2048x1536px
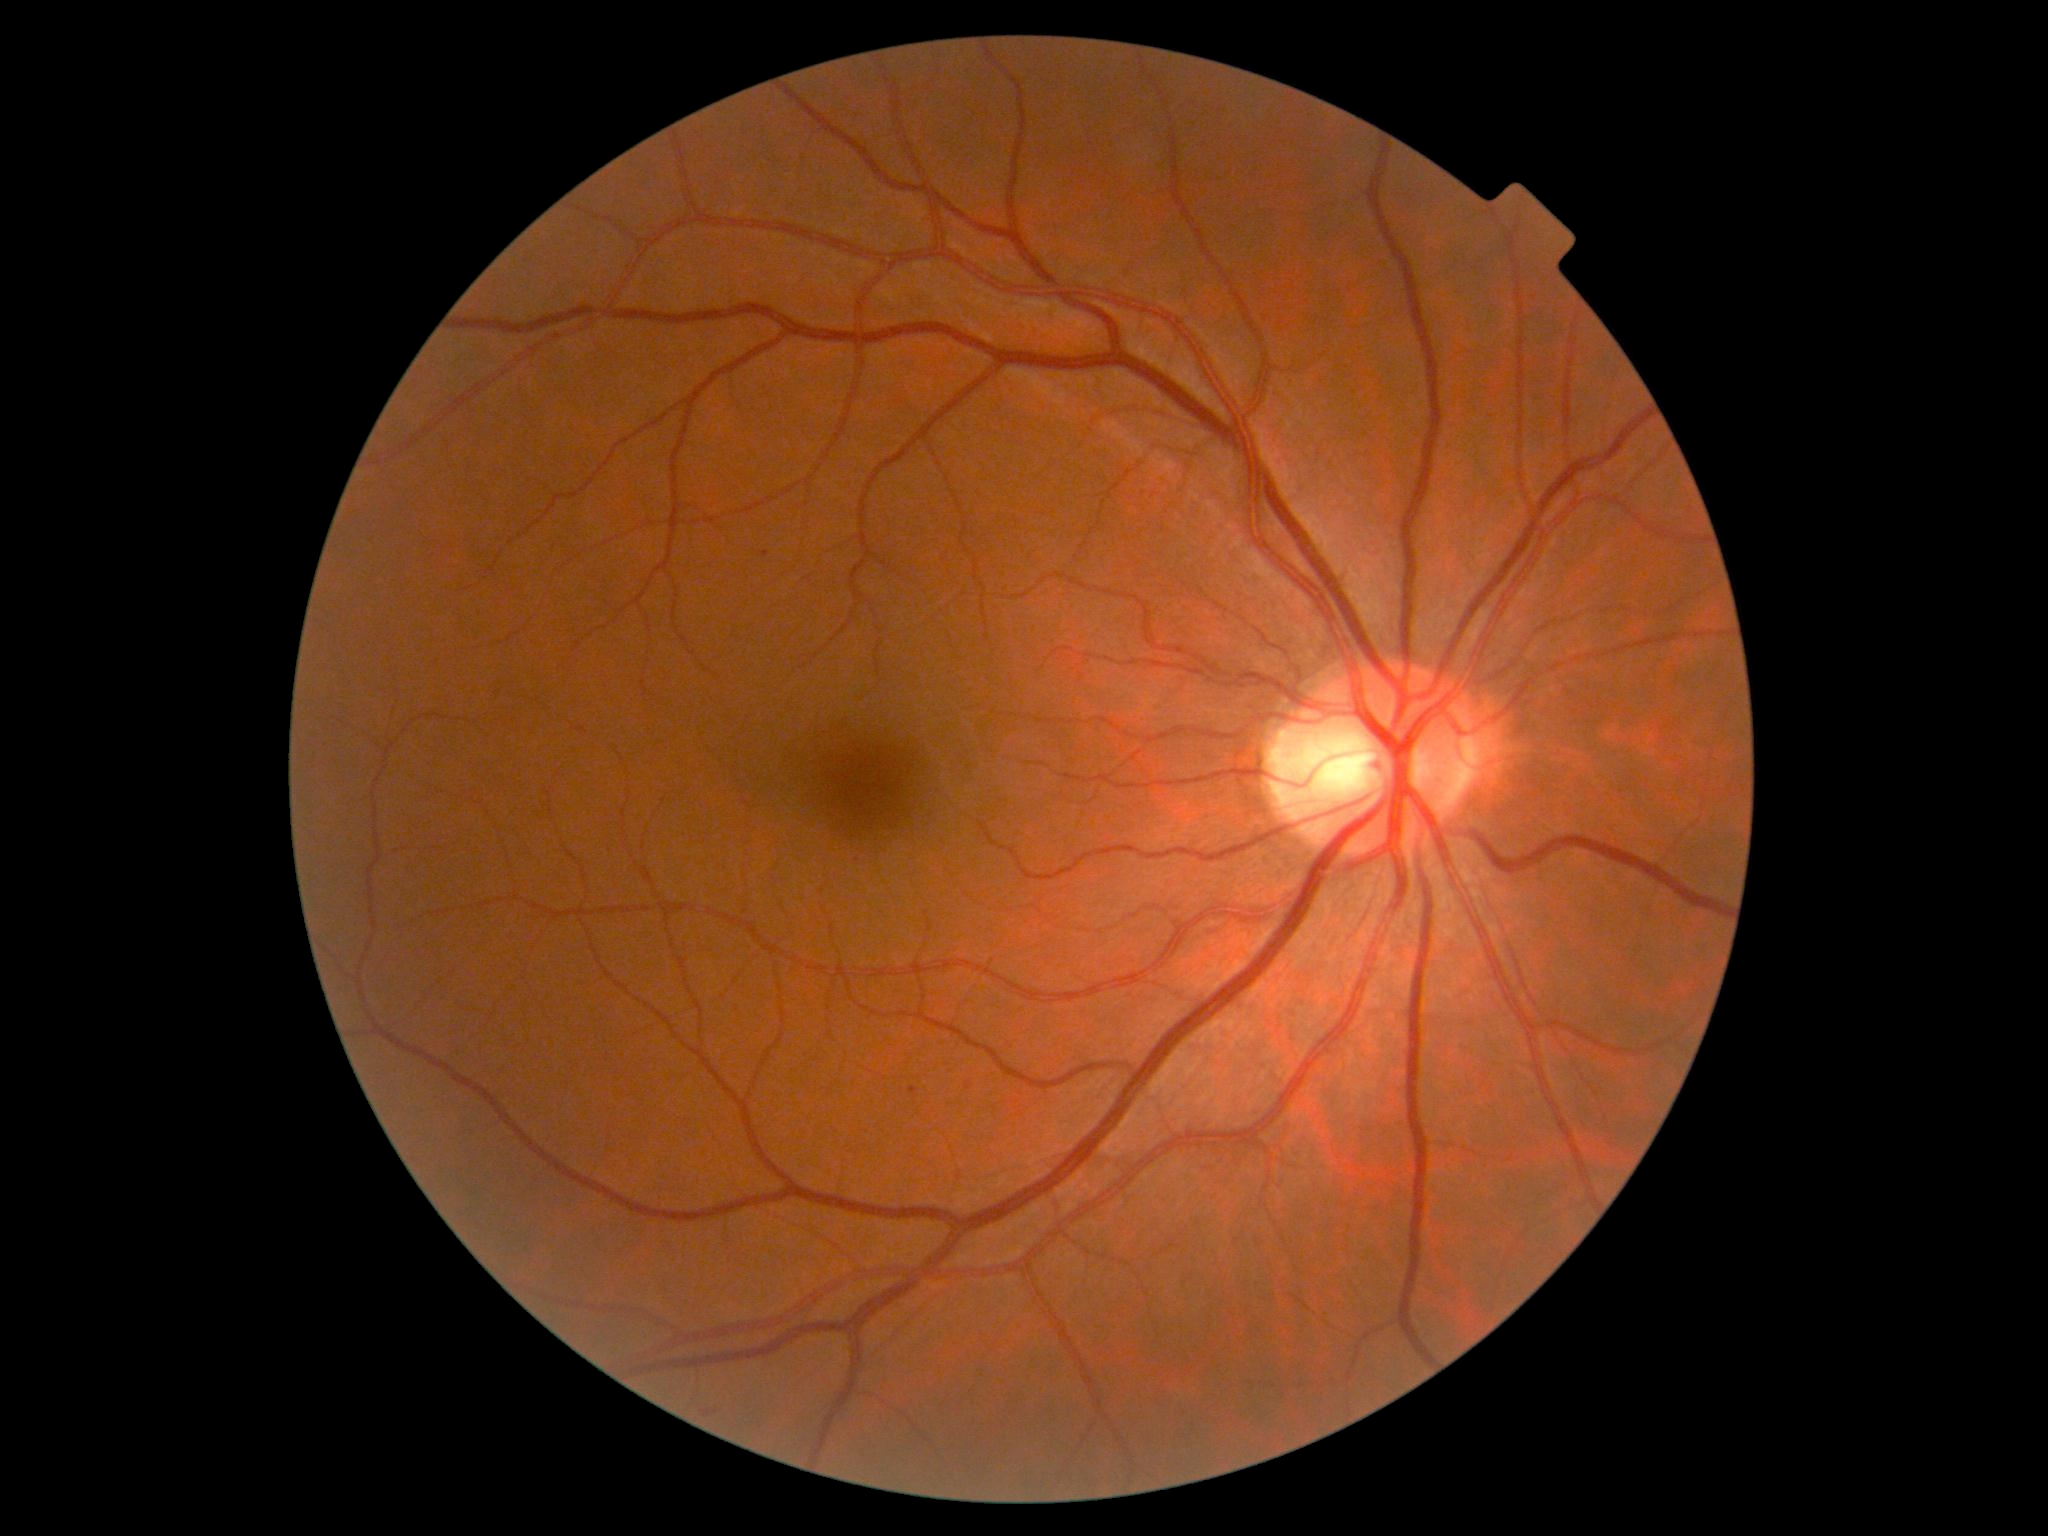

Annotations:
– diabetic retinopathy severity — grade 1
– DR class — non-proliferative diabetic retinopathy